Fundus photo
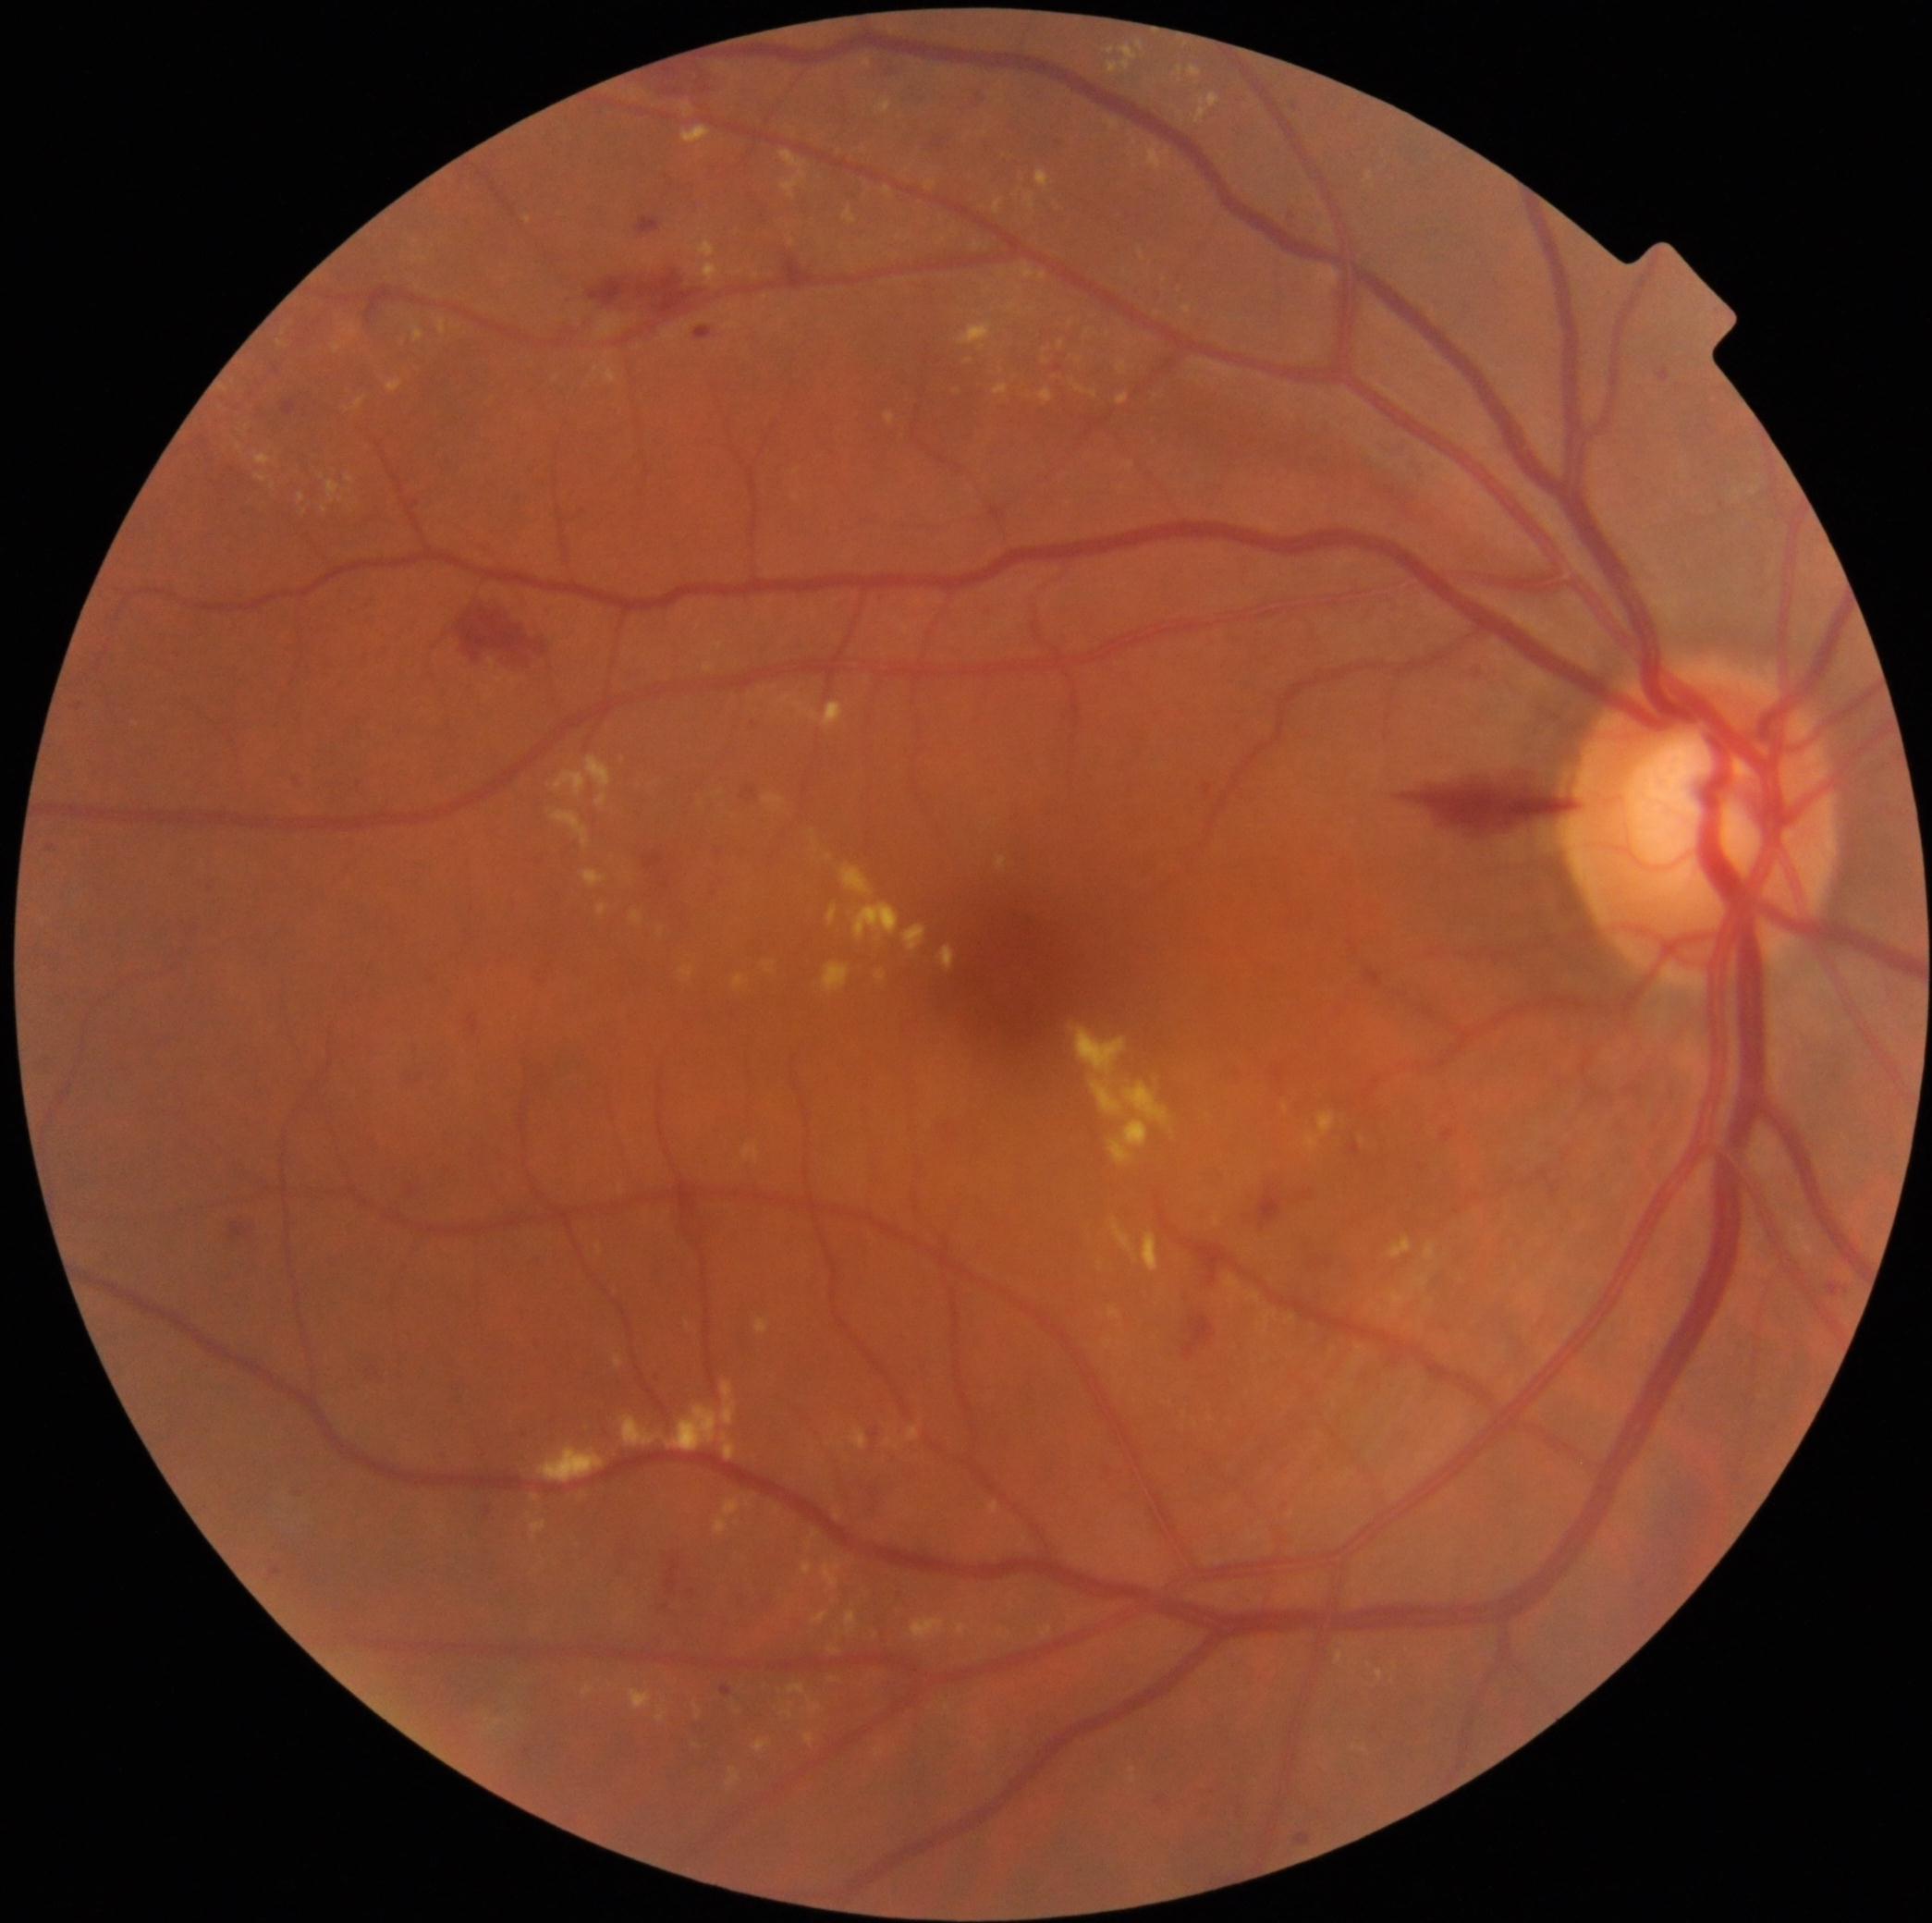
Diabetic retinopathy is 2 — more than just microaneurysms but less than severe NPDR
A subset of detected lesions:
hard exudates (partial): BBox(1025, 193, 1036, 211) | BBox(1104, 1339, 1113, 1349) | BBox(885, 1439, 899, 1450) | BBox(885, 412, 896, 425) | BBox(255, 454, 273, 467) | BBox(1072, 383, 1098, 399) | BBox(1387, 1273, 1430, 1318) | BBox(658, 1708, 667, 1721) | BBox(958, 321, 994, 351) | BBox(724, 1499, 740, 1517) | BBox(237, 445, 242, 454) | BBox(1147, 145, 1171, 171) | BBox(1366, 173, 1374, 182)
Hard exudates (small, approximate centers) near (1046,362) | (284,333) | (778,1510) | (1287,1108) | (1355,1747) | (1071,323)